1380 by 1382 pixels — 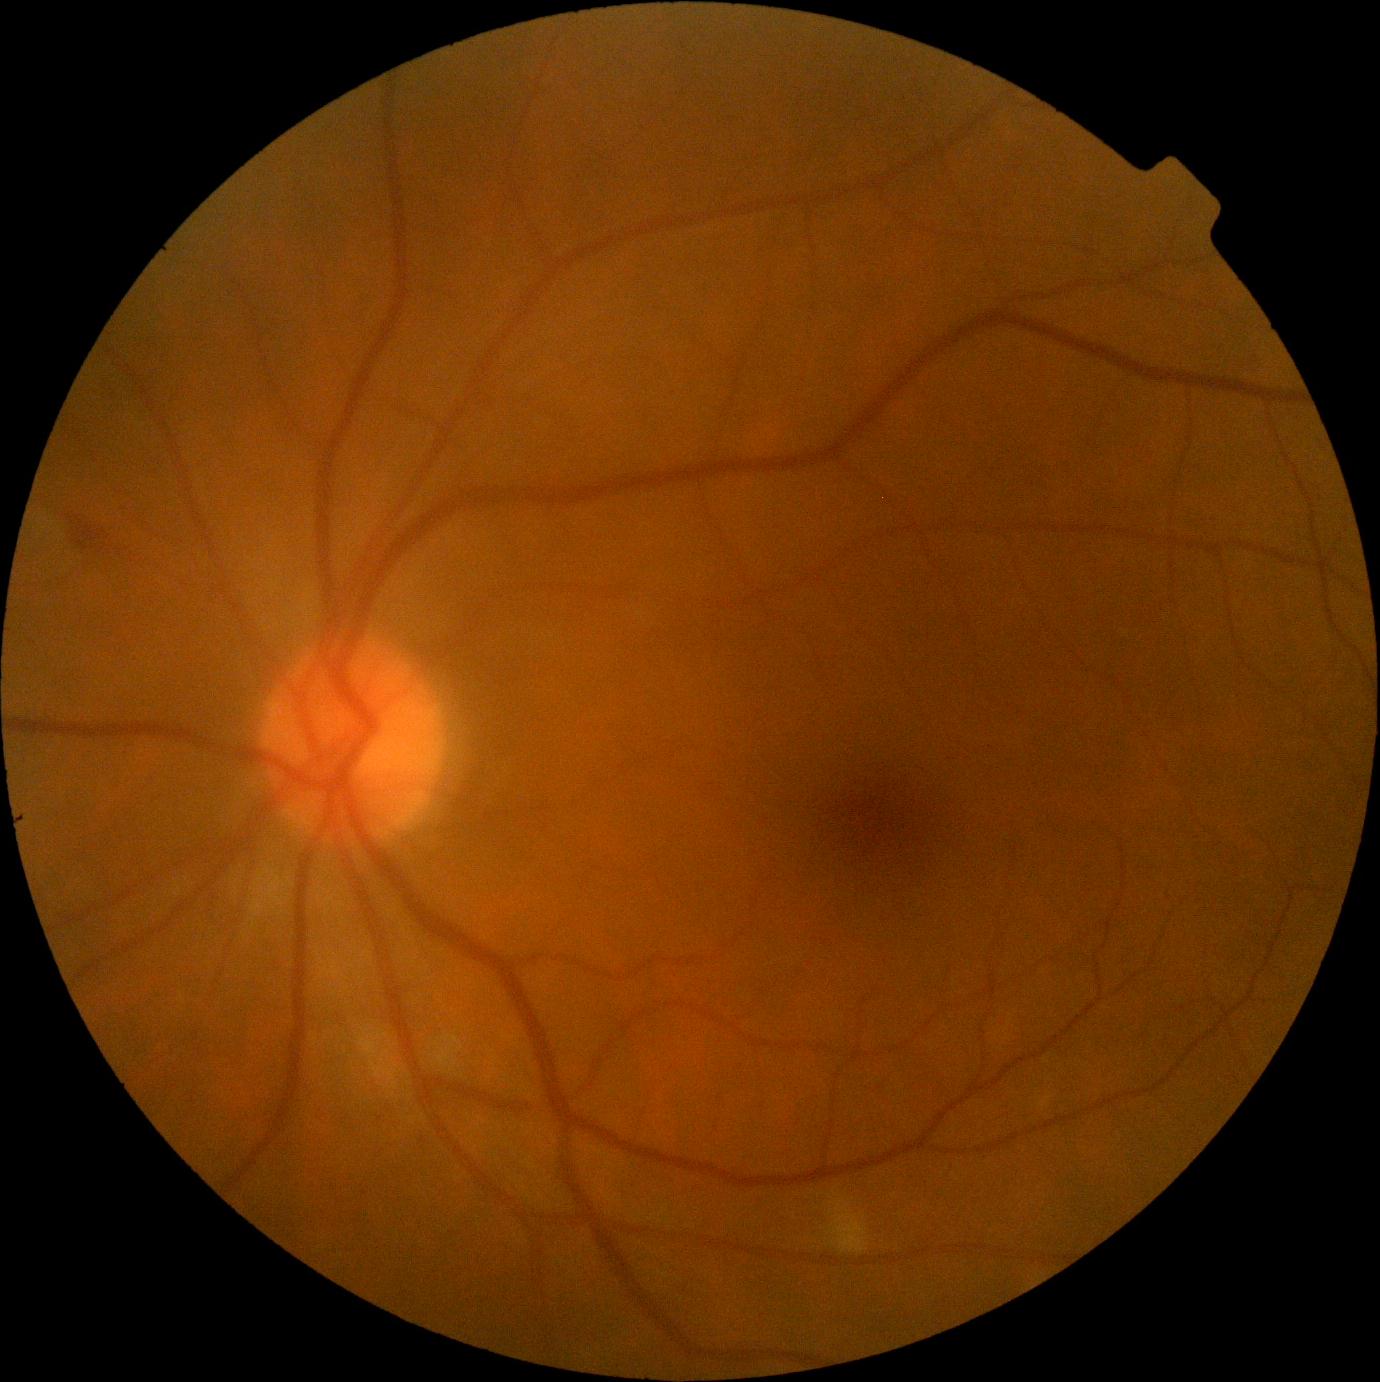 DR class = non-proliferative diabetic retinopathy
DR stage = 2 — more than just microaneurysms but less than severe NPDR